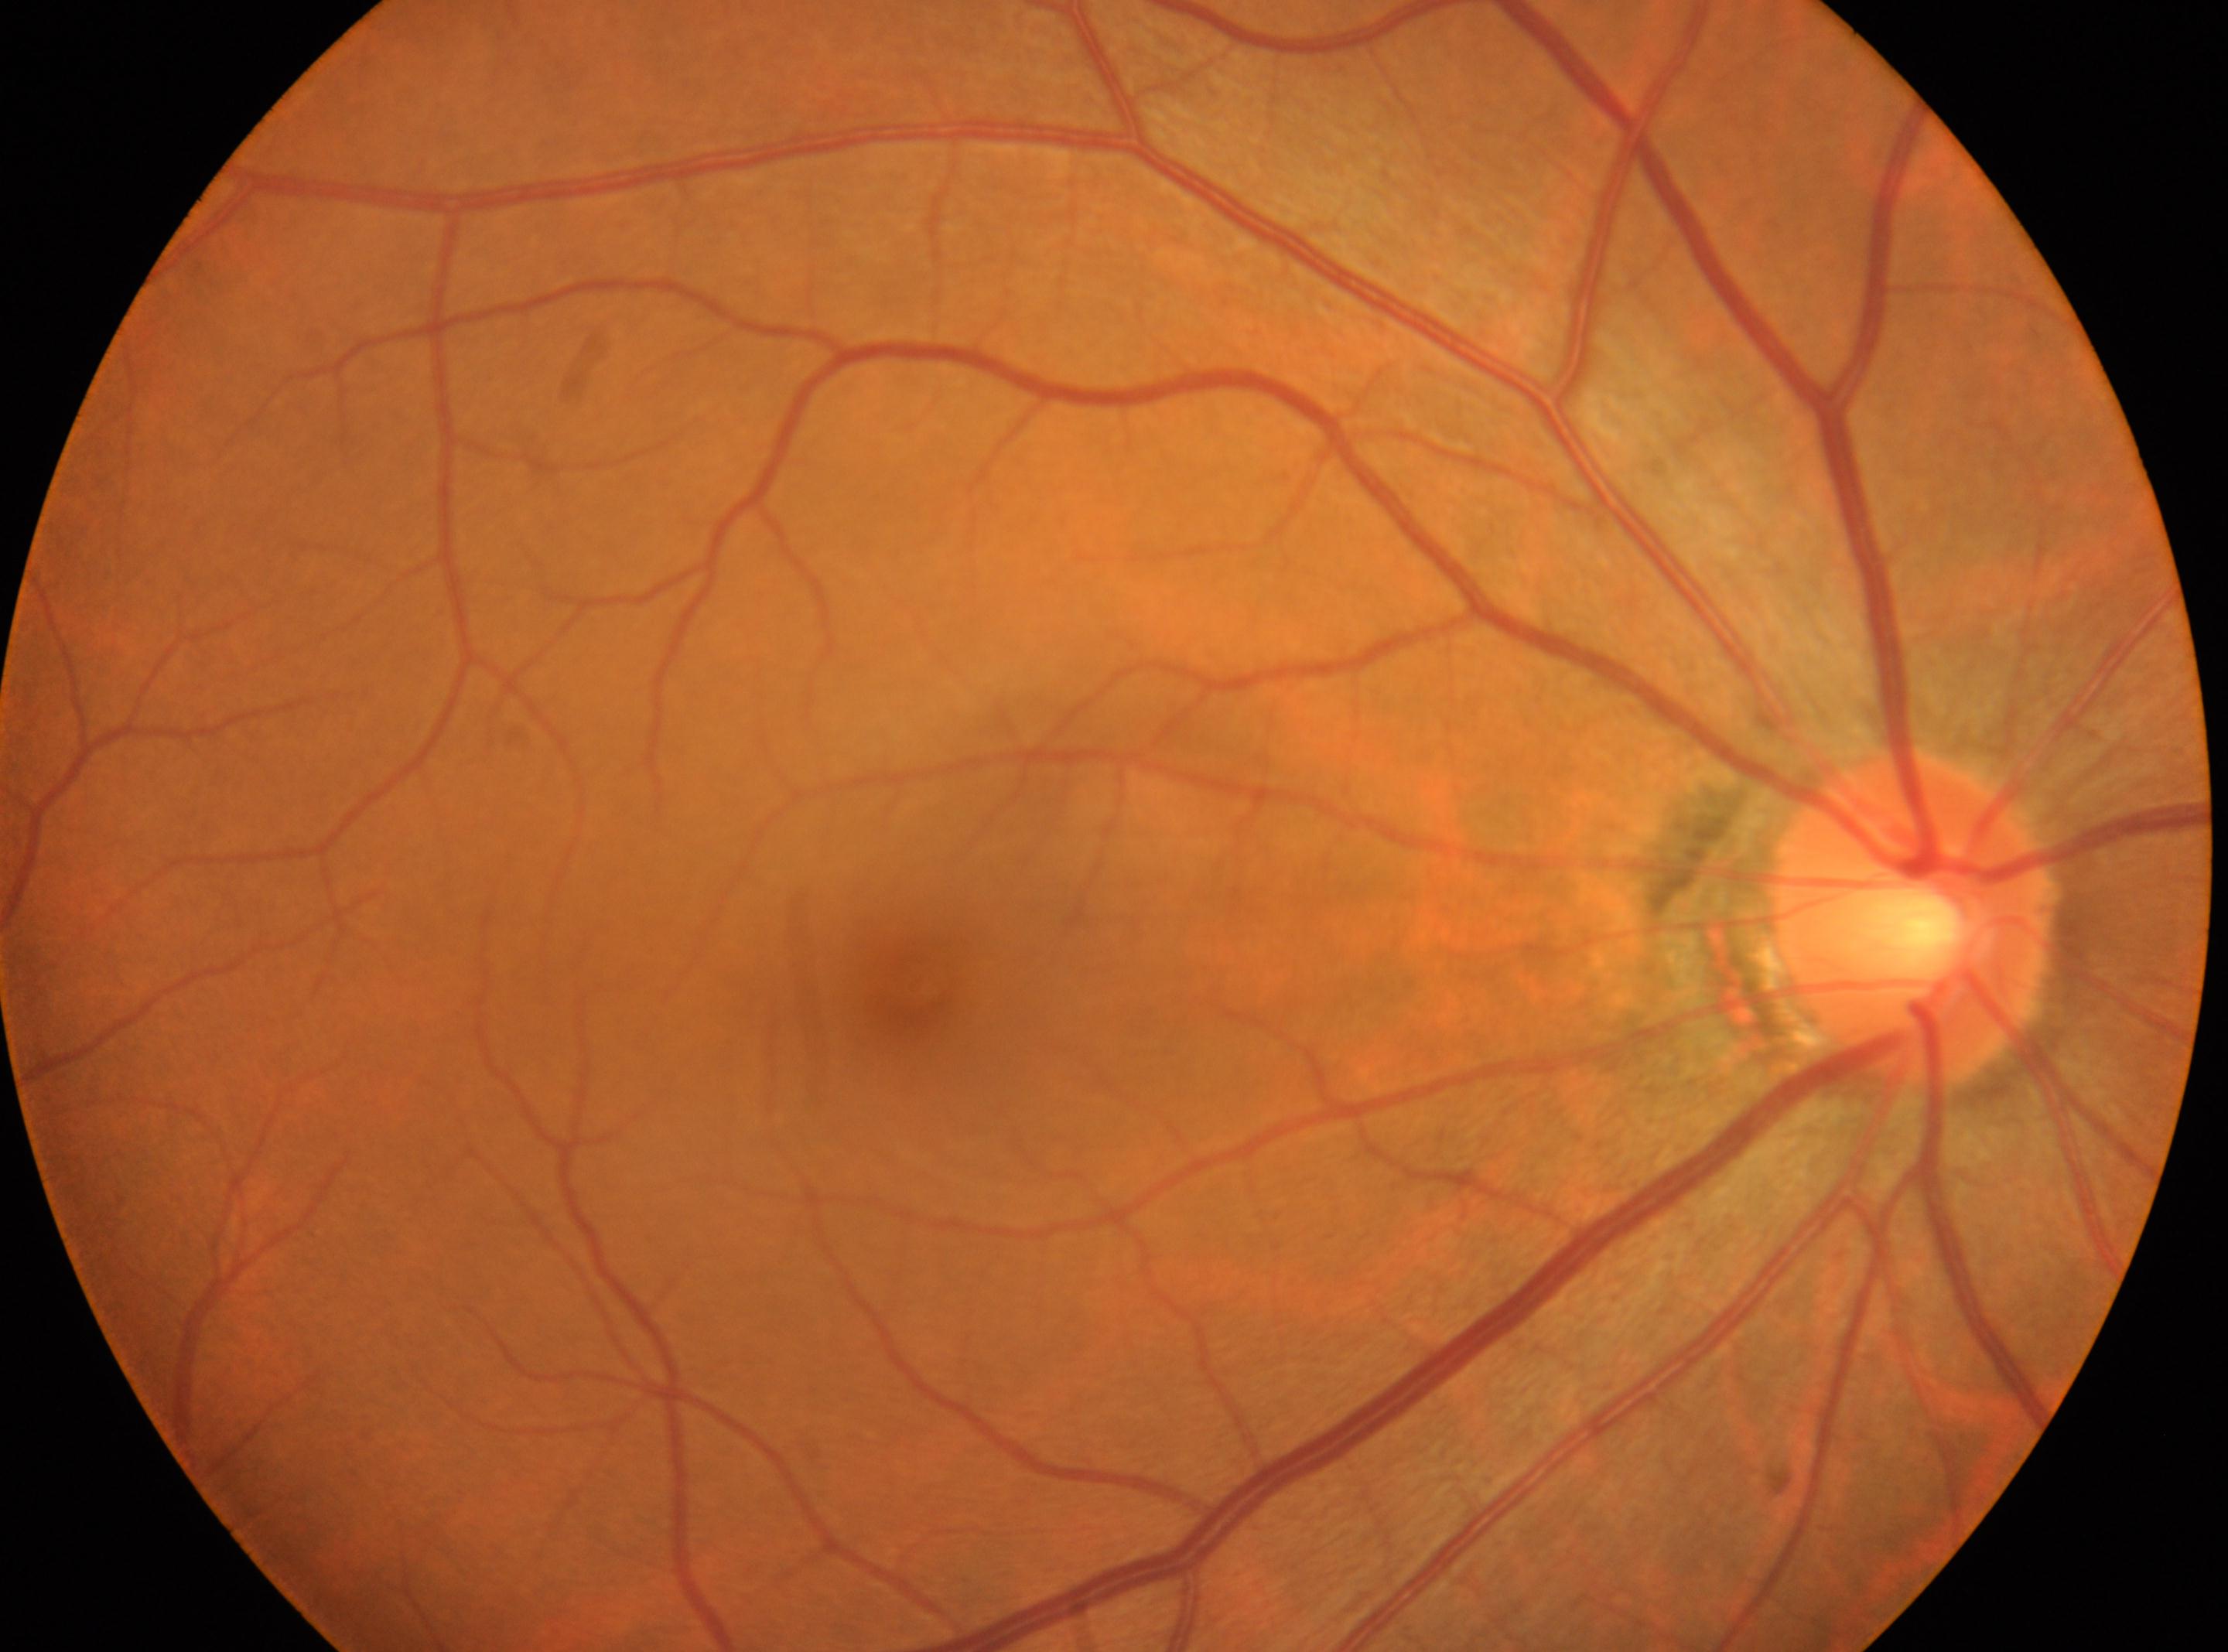
Q: What is the laterality?
A: right
Q: What is the DR grade?
A: grade 0
Q: Where is the fovea?
A: (x=914, y=984)
Q: Where is the optic disc?
A: (x=1917, y=919)